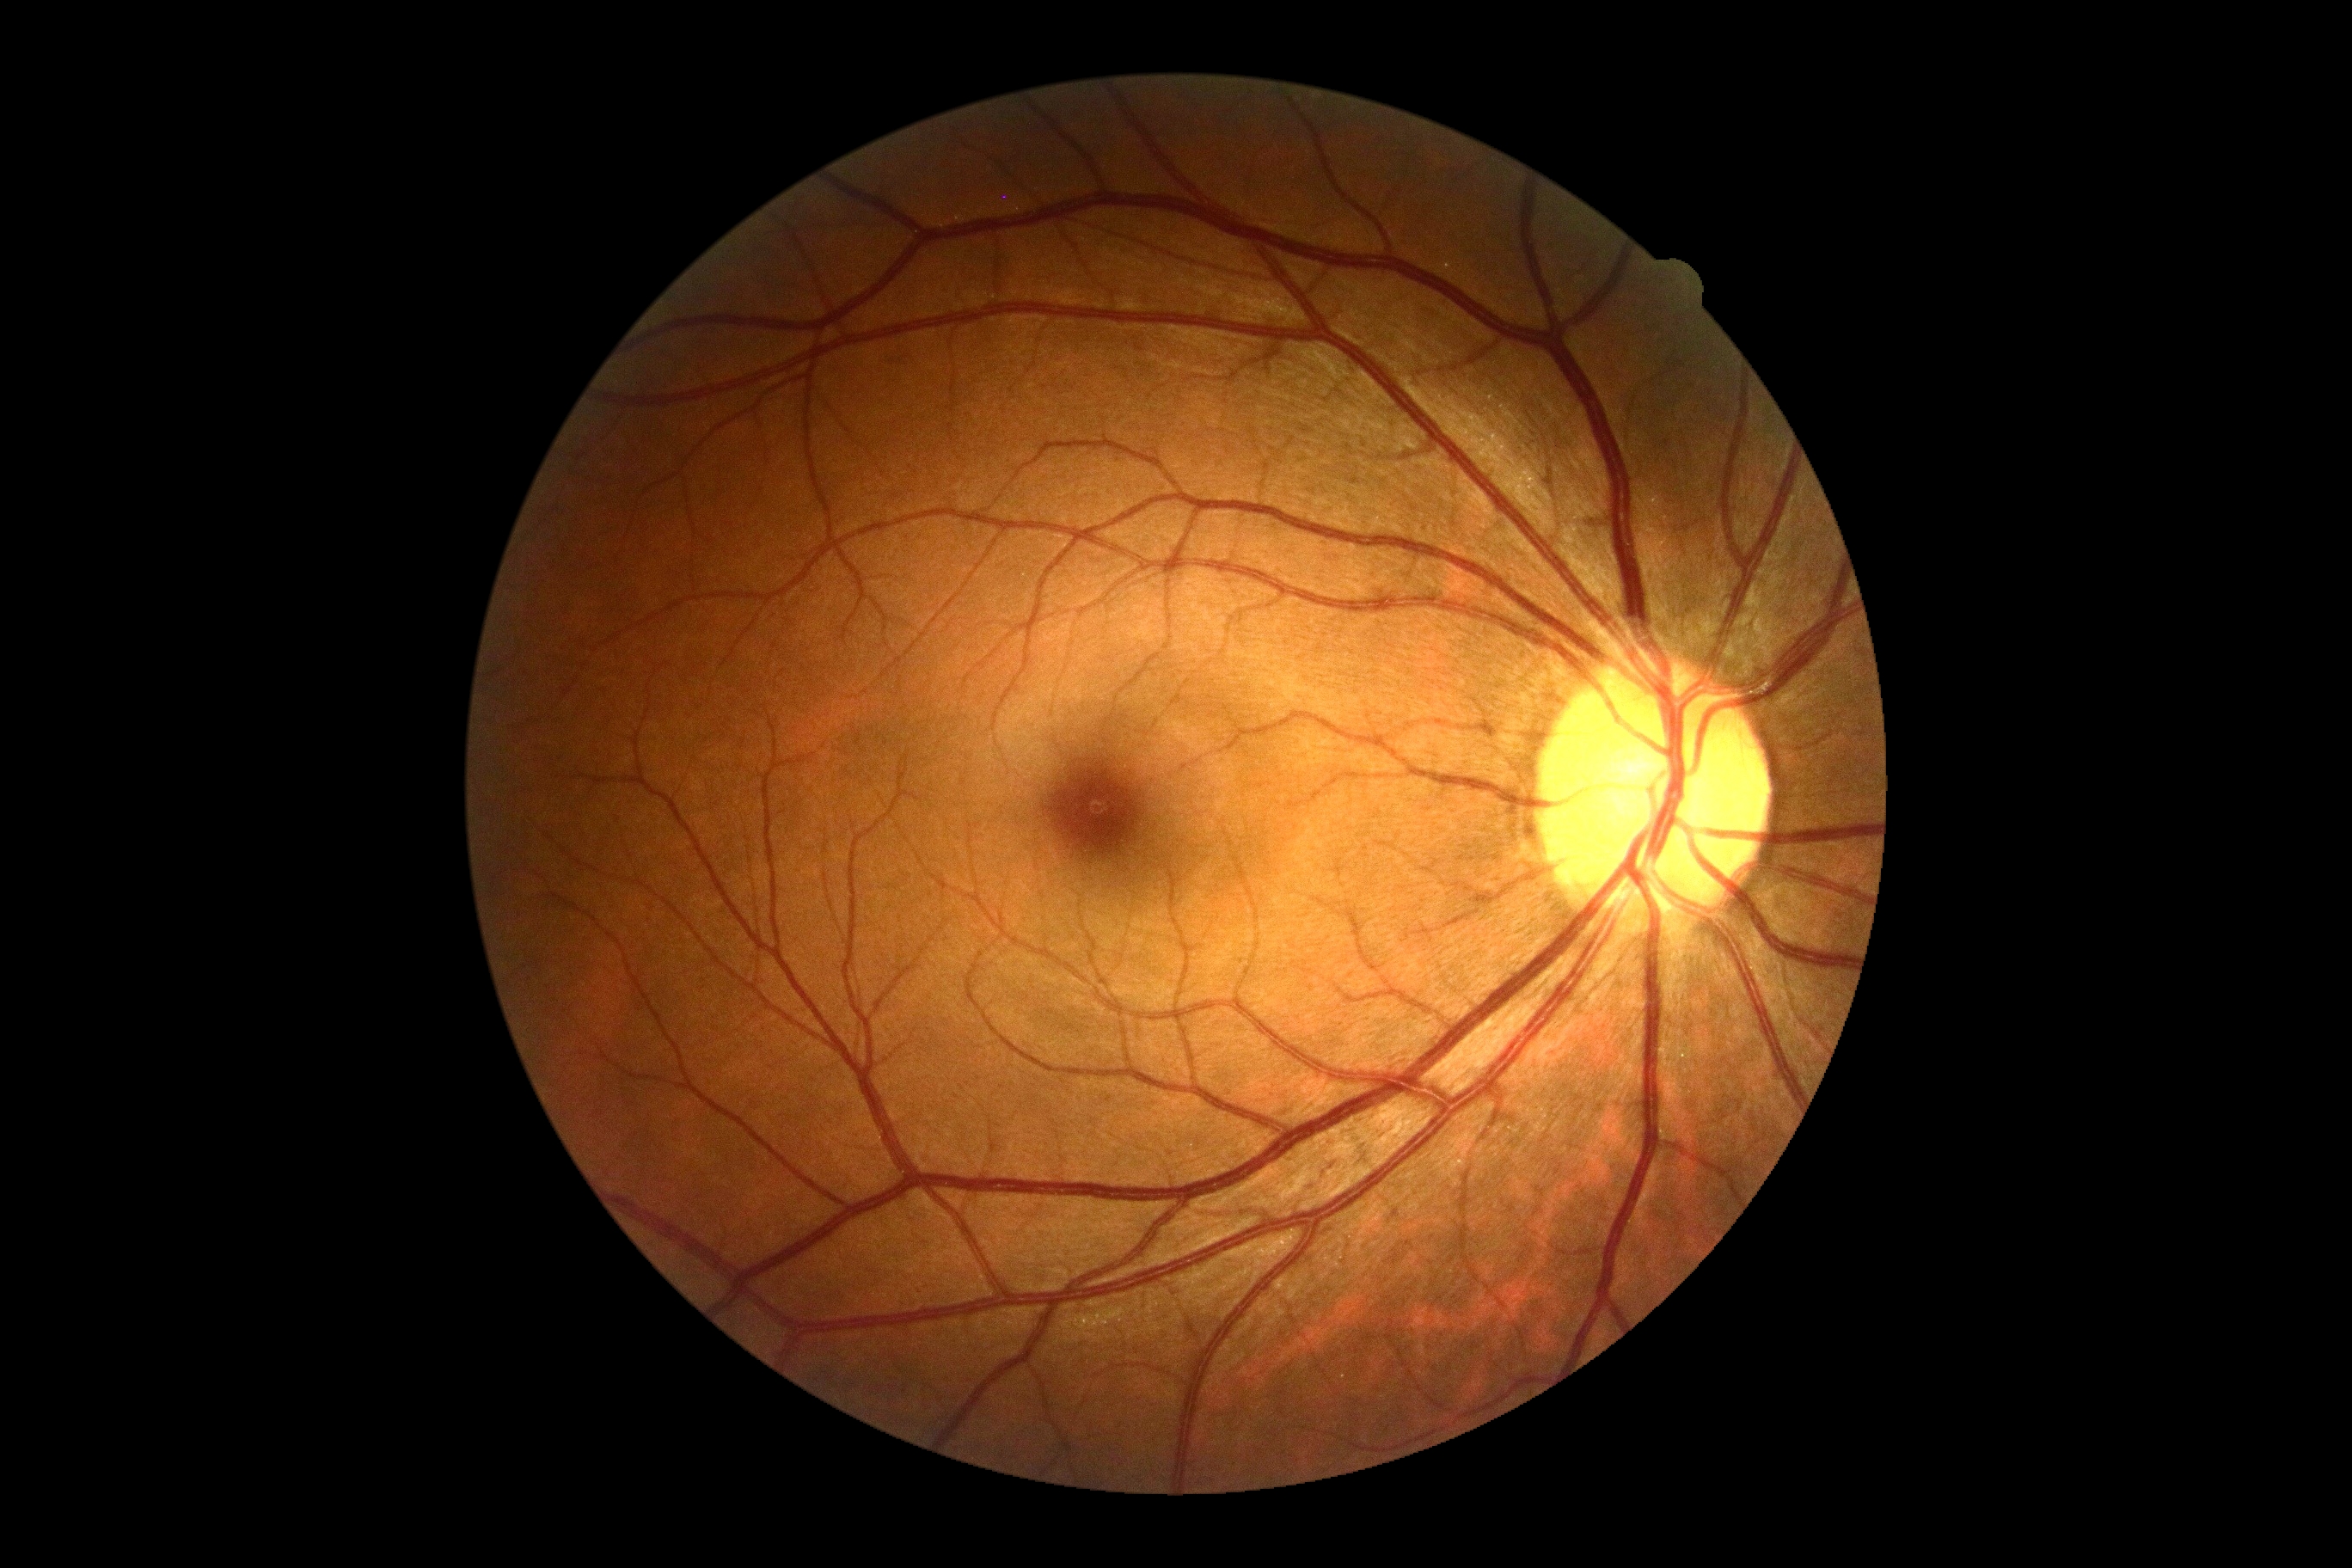 Retinopathy grade is no apparent retinopathy (0).